Retinal fundus photograph
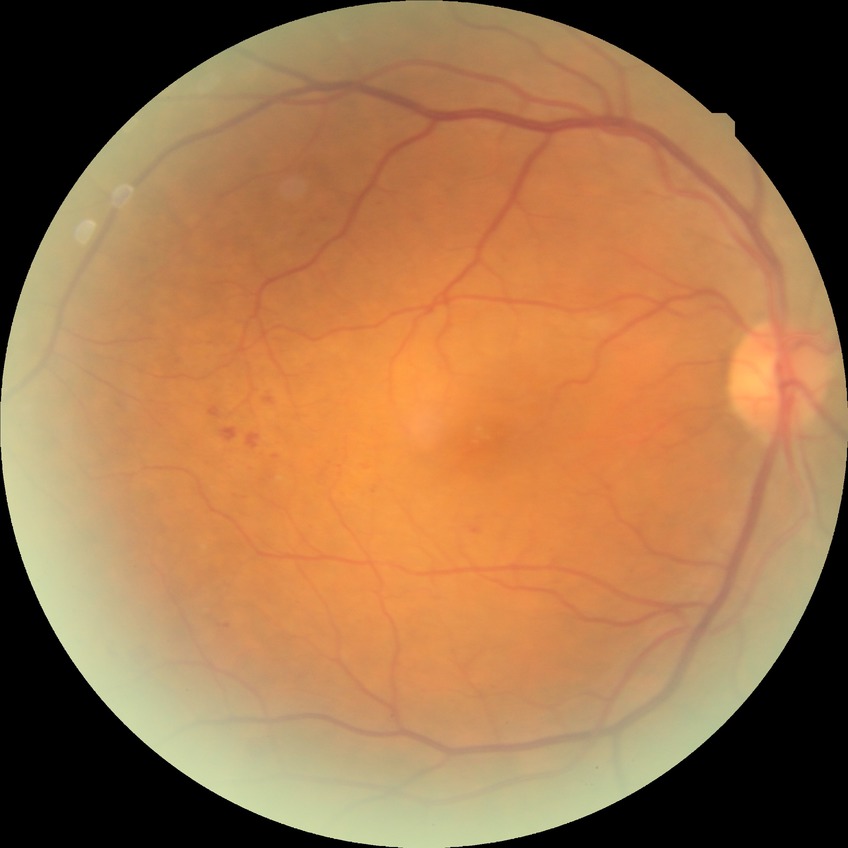
Diabetic retinopathy (DR): simple diabetic retinopathy (SDR).